Color fundus image · 50° FOV — 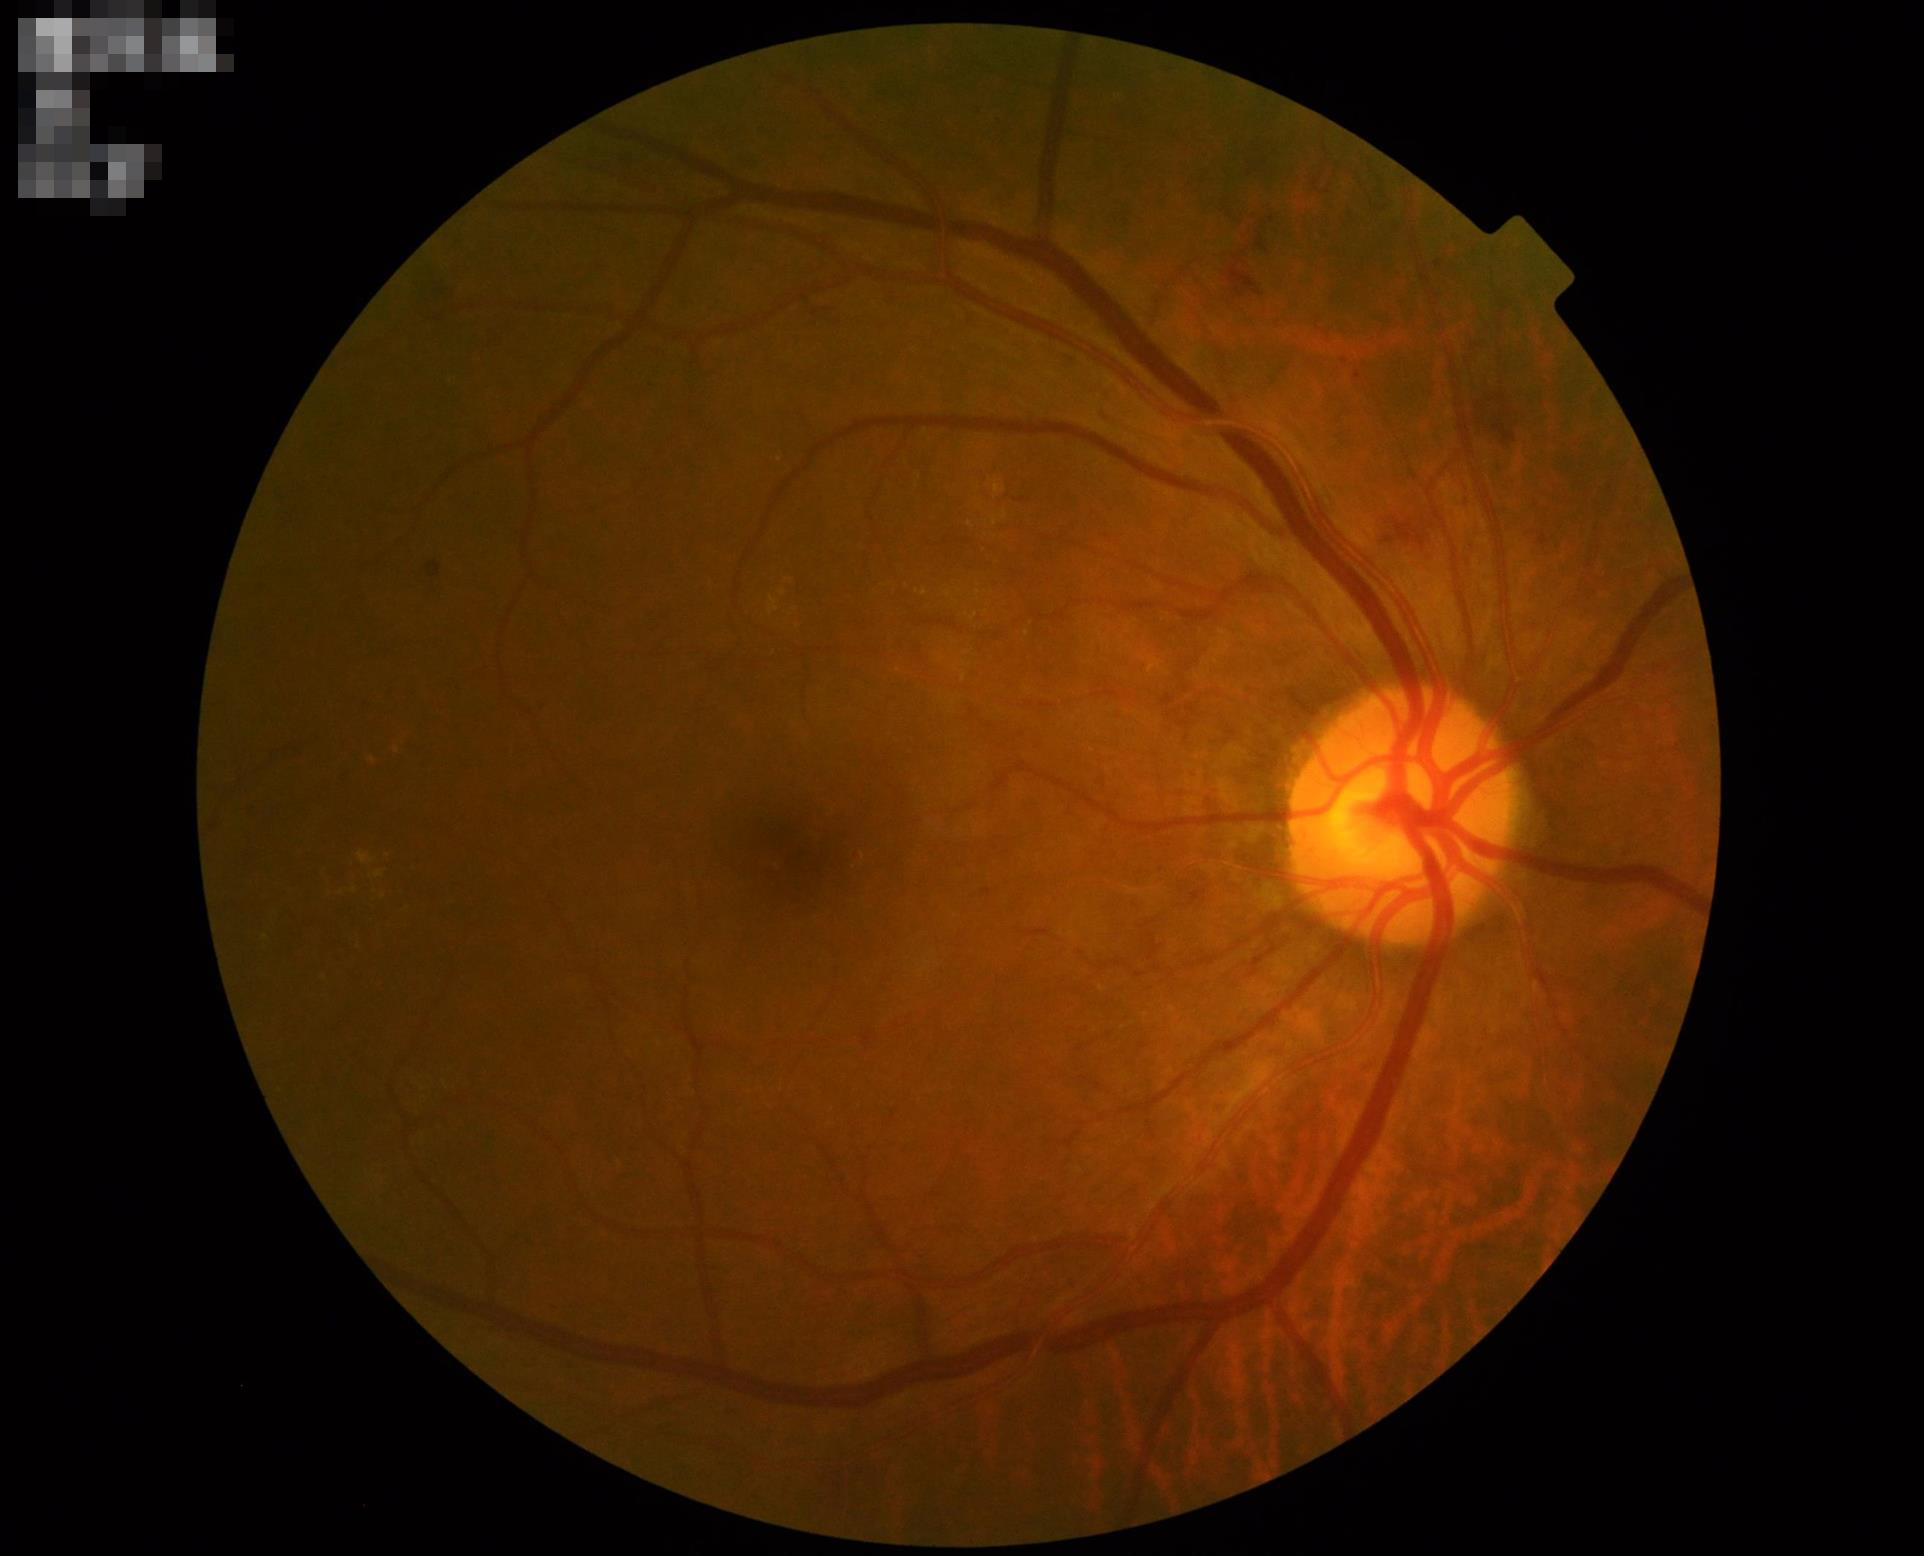
No over- or under-exposure.
Image is sharp throughout the field.
Good dynamic range.
Overall quality is good and the image is gradable.